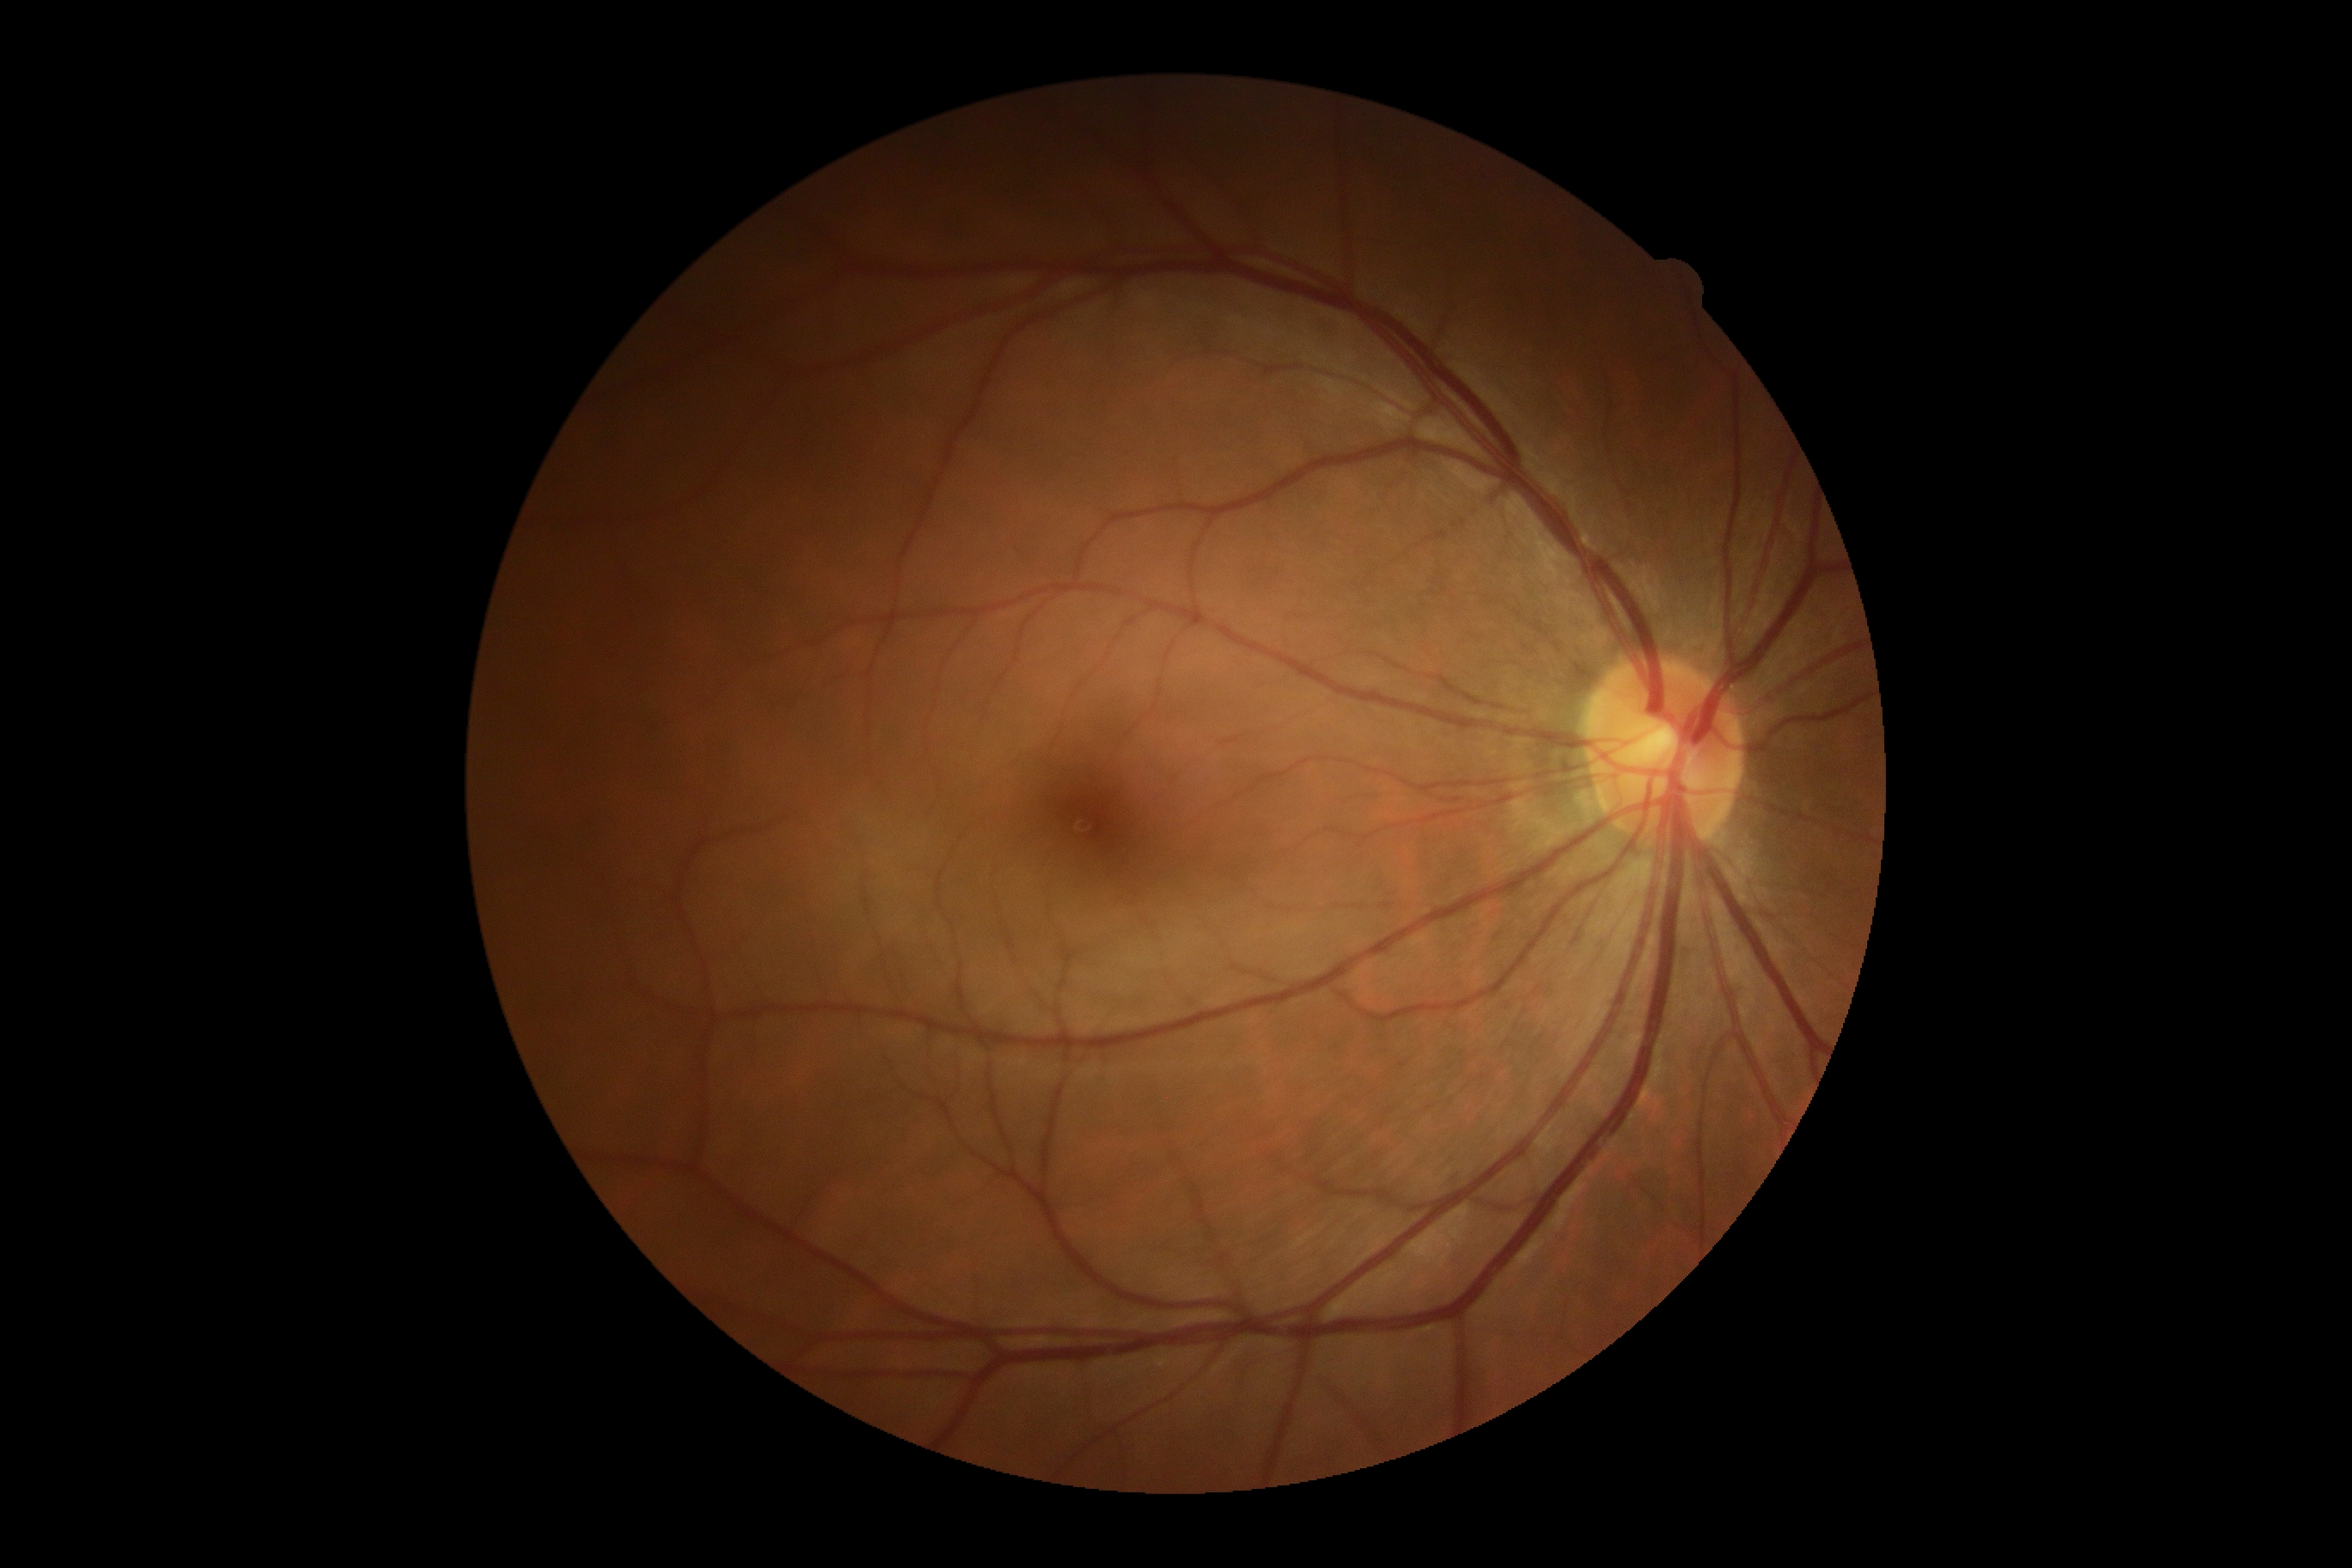
DR severity is grade 0.